Graded on the modified Davis scale — 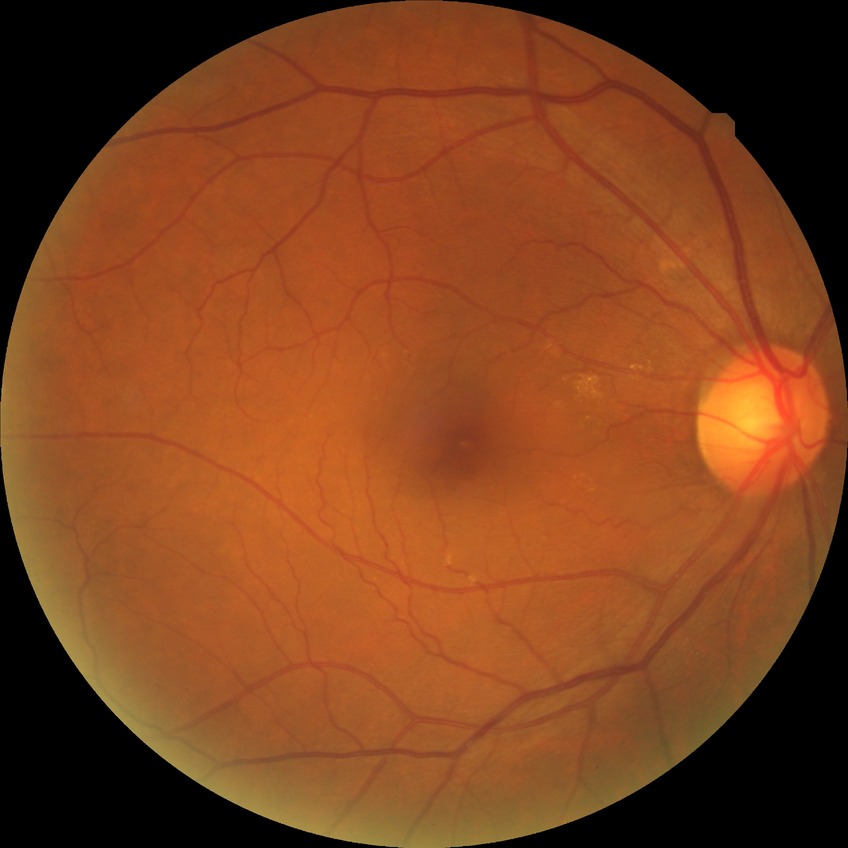 • diabetic retinopathy (DR): no diabetic retinopathy (NDR)